Nonmydriatic. Fundus photo. FOV: 45 degrees: 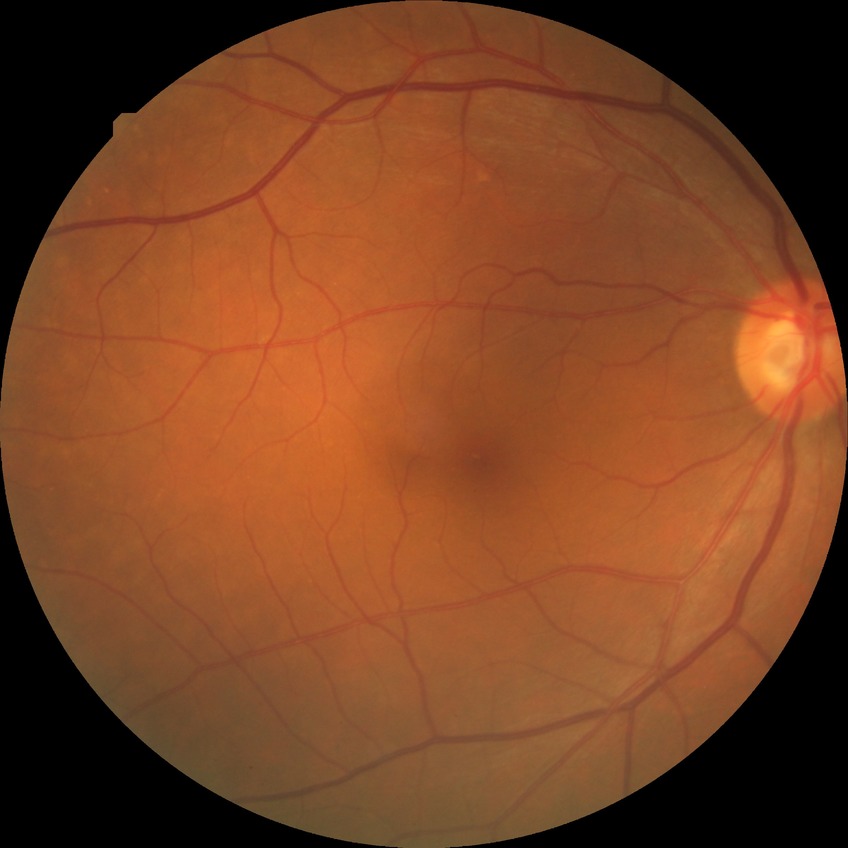
DR grade = NDR